1659 by 2212 pixels — 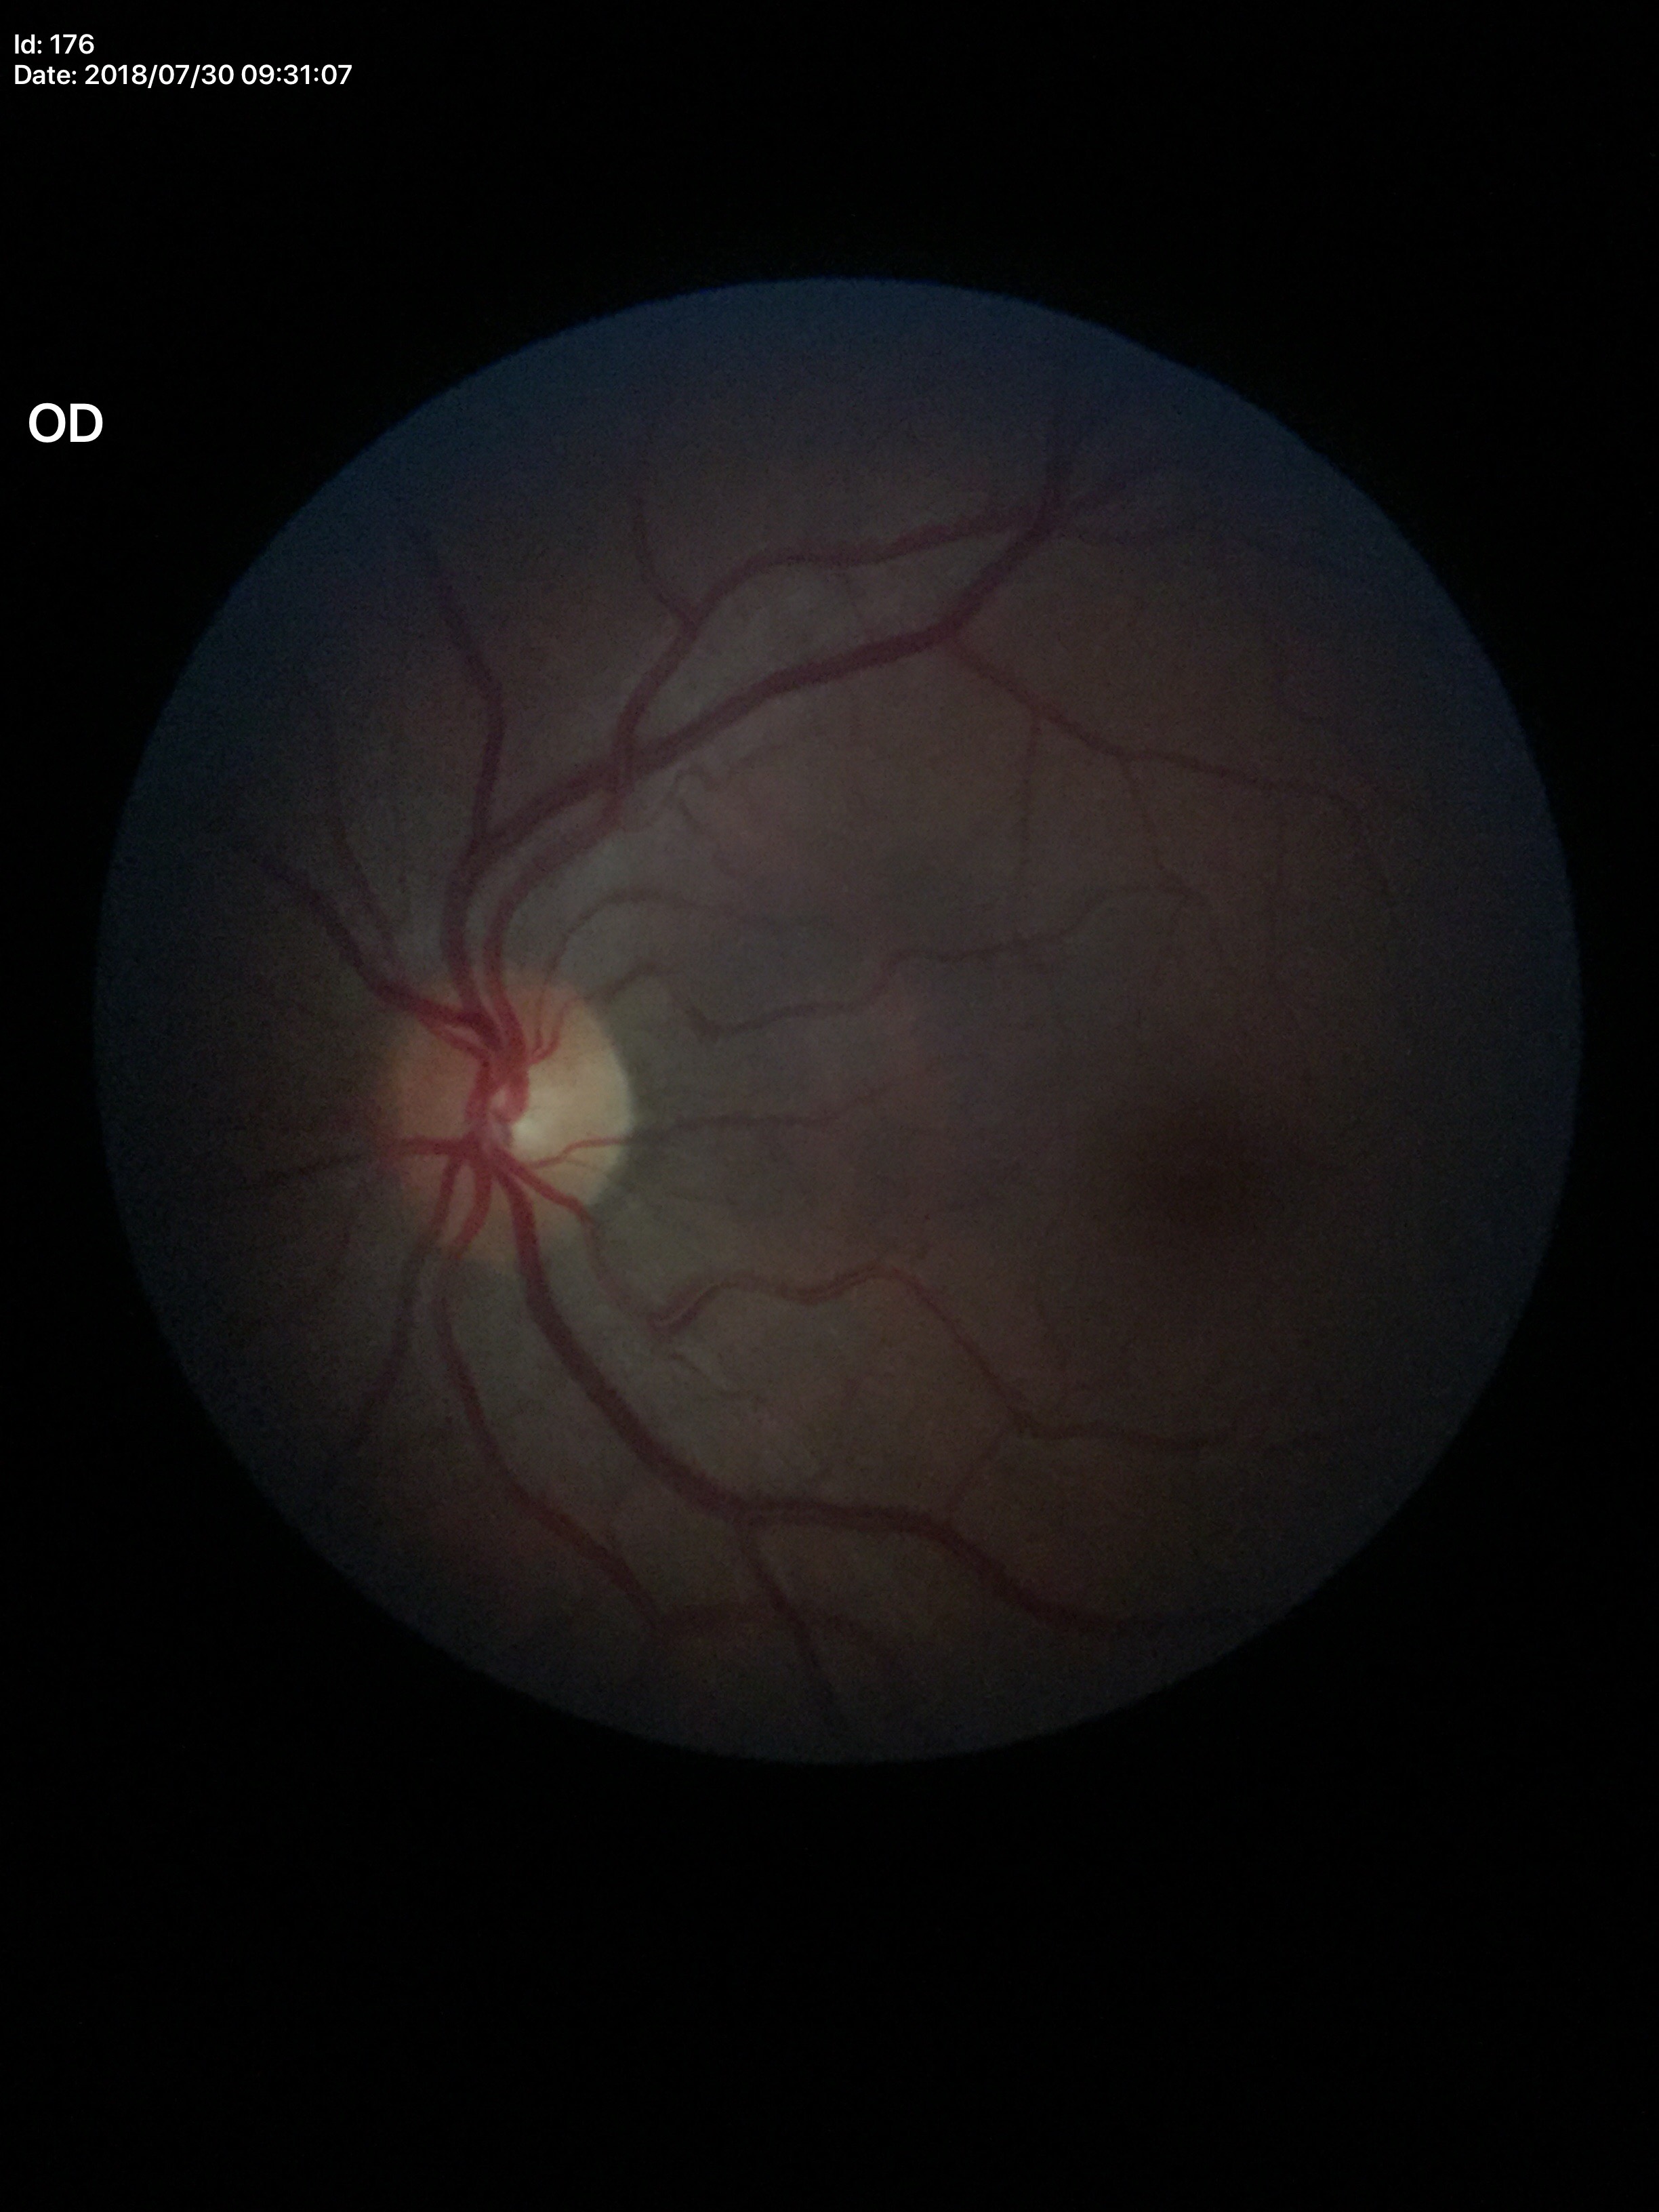 Glaucoma impression: negative (all 5 graders called normal). Horizontal cup-disc ratio is 0.49. Vertical cup-disc ratio is 0.51.